Image size 1440x1080. Wide-field fundus image from infant ROP screening:
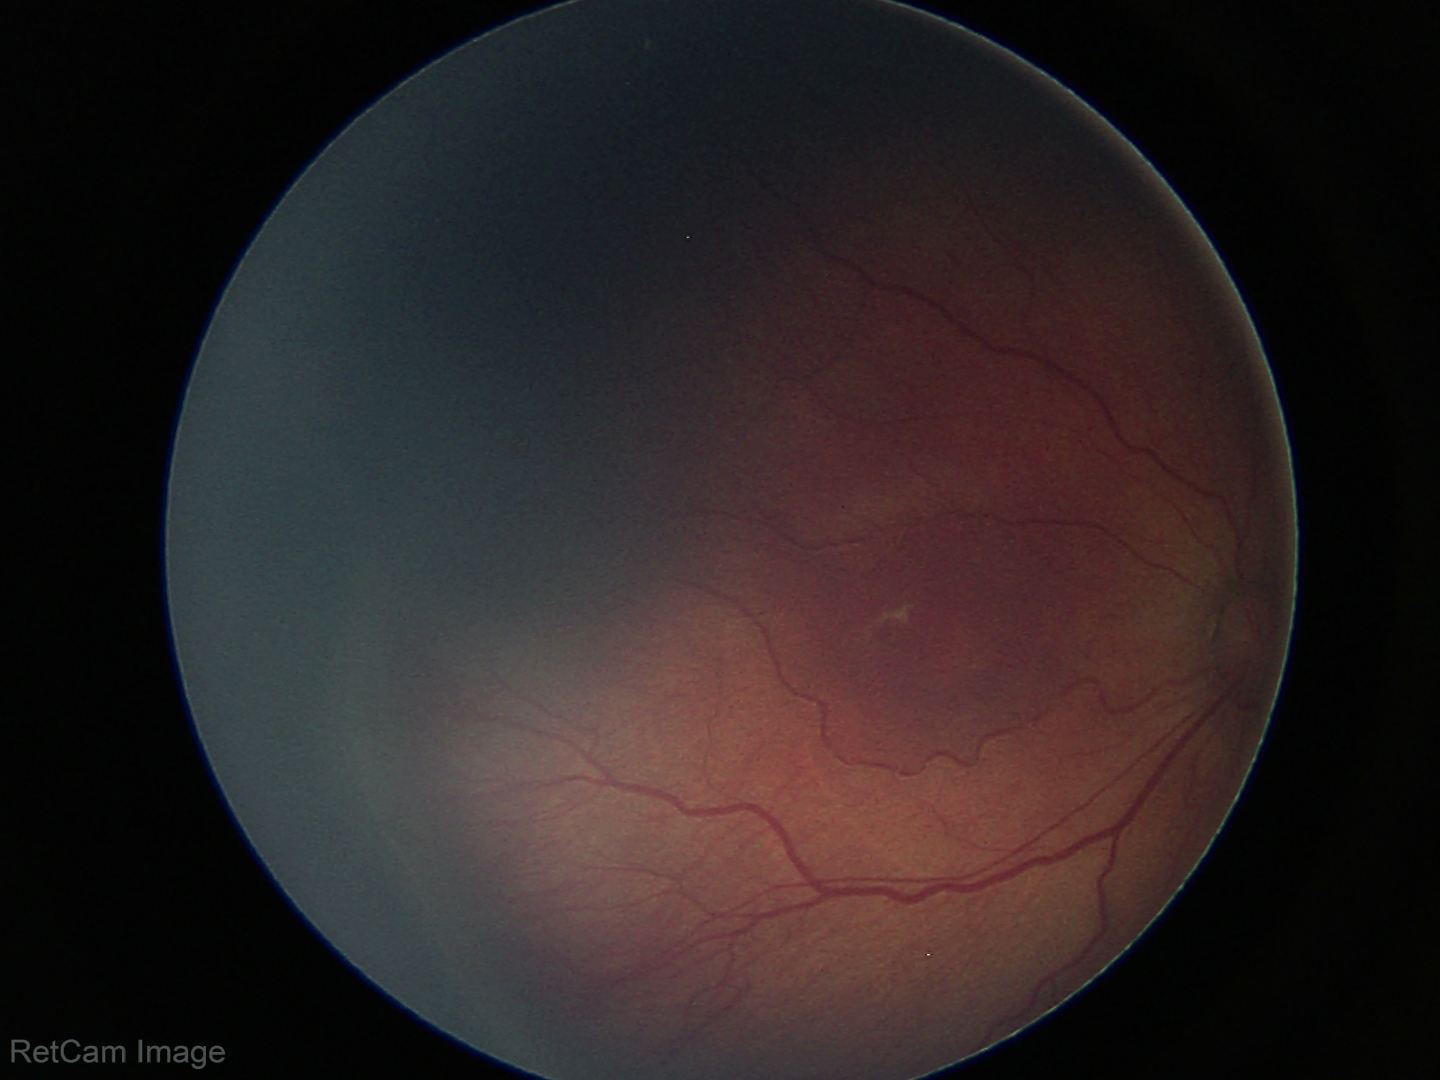
From an examination with diagnosis of retinopathy of prematurity (ROP) stage 3.